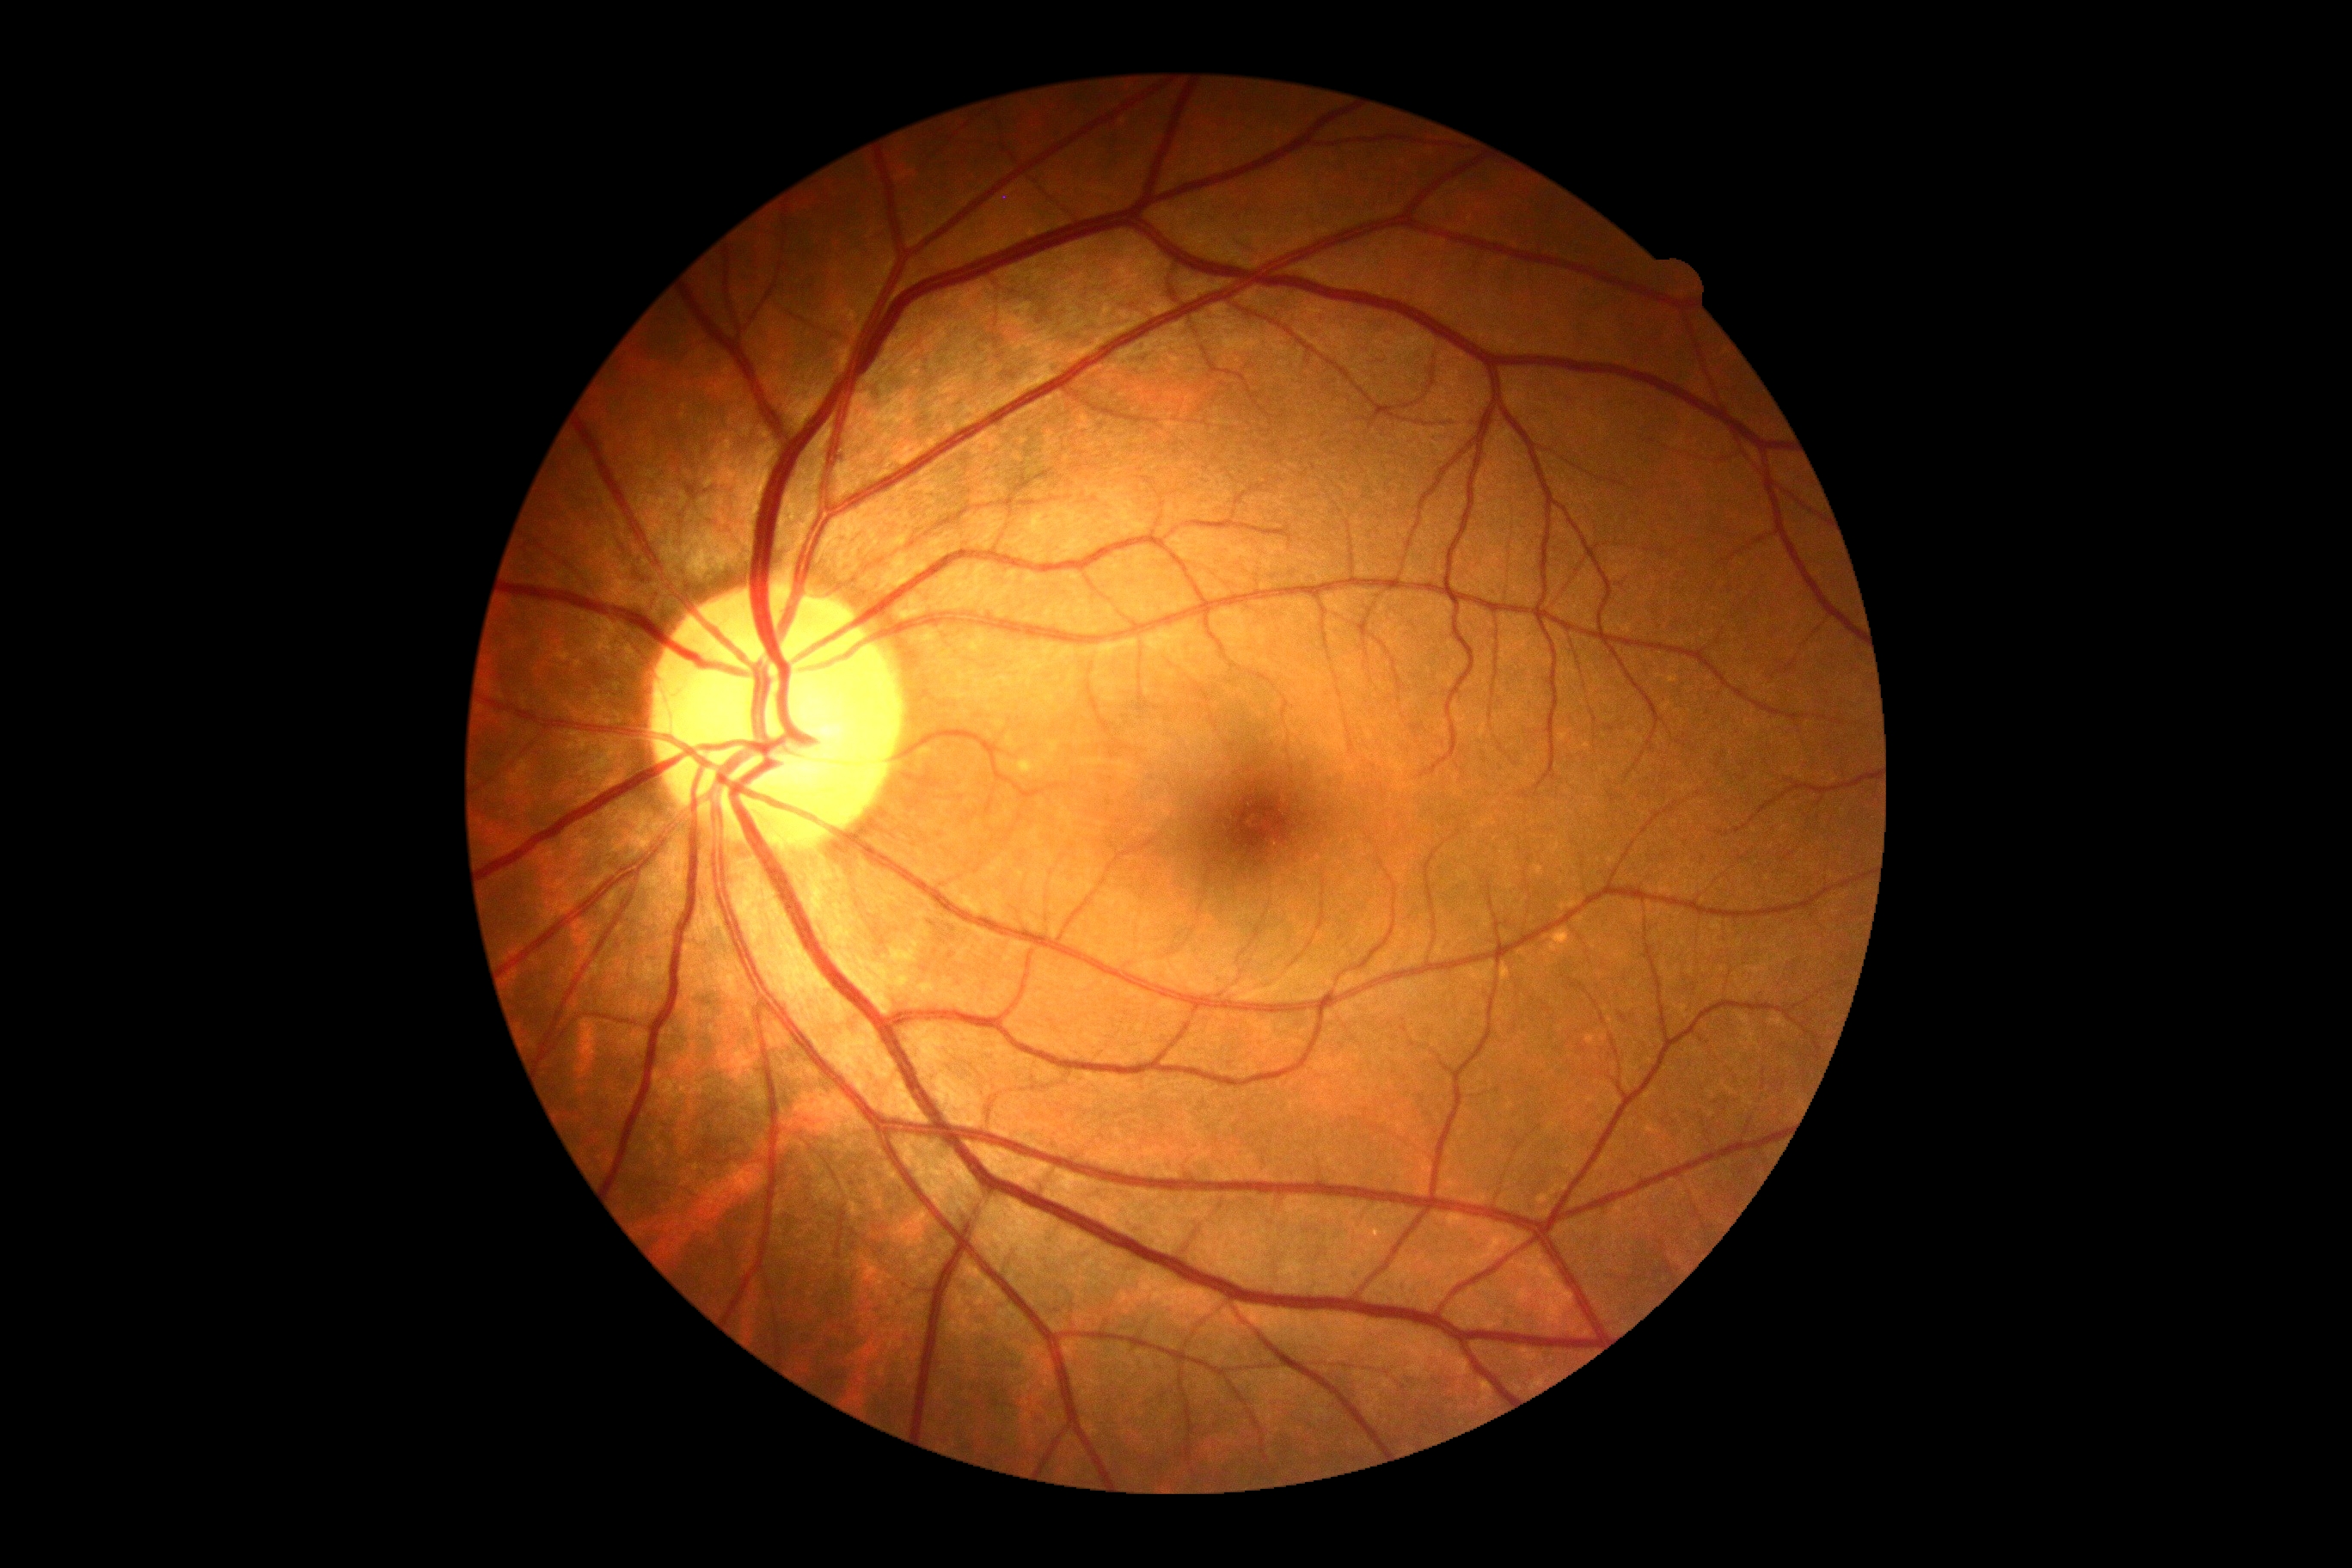 Diabetic retinopathy is grade 0 (no apparent retinopathy).